848x848px: 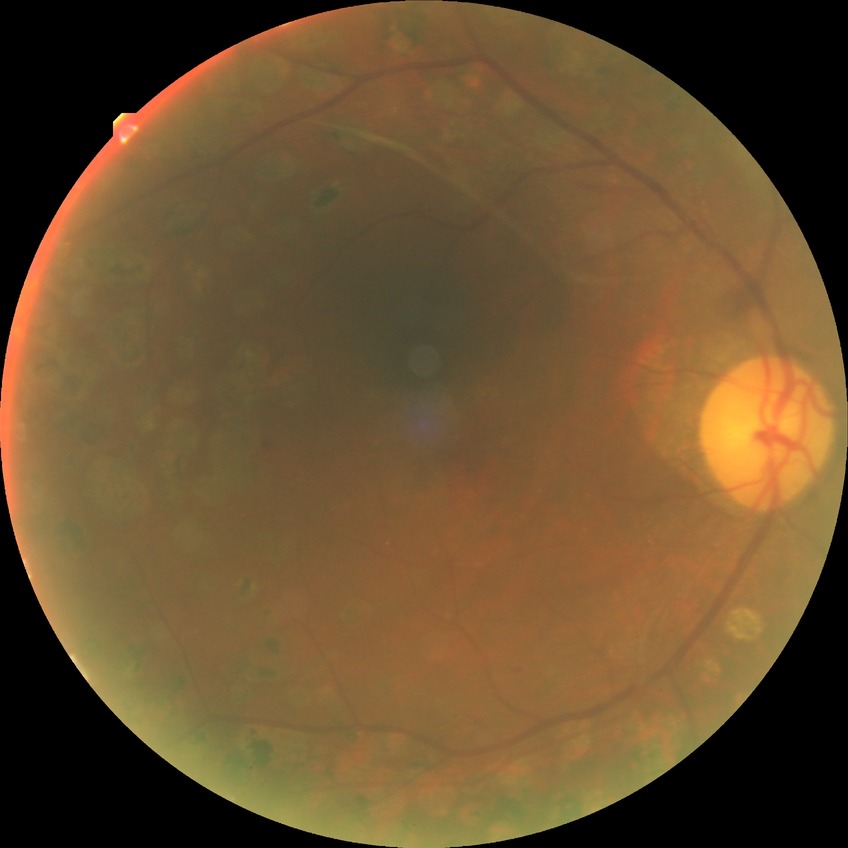

davis_grade: proliferative diabetic retinopathy